Fundus photo; 1924 x 1556 pixels: 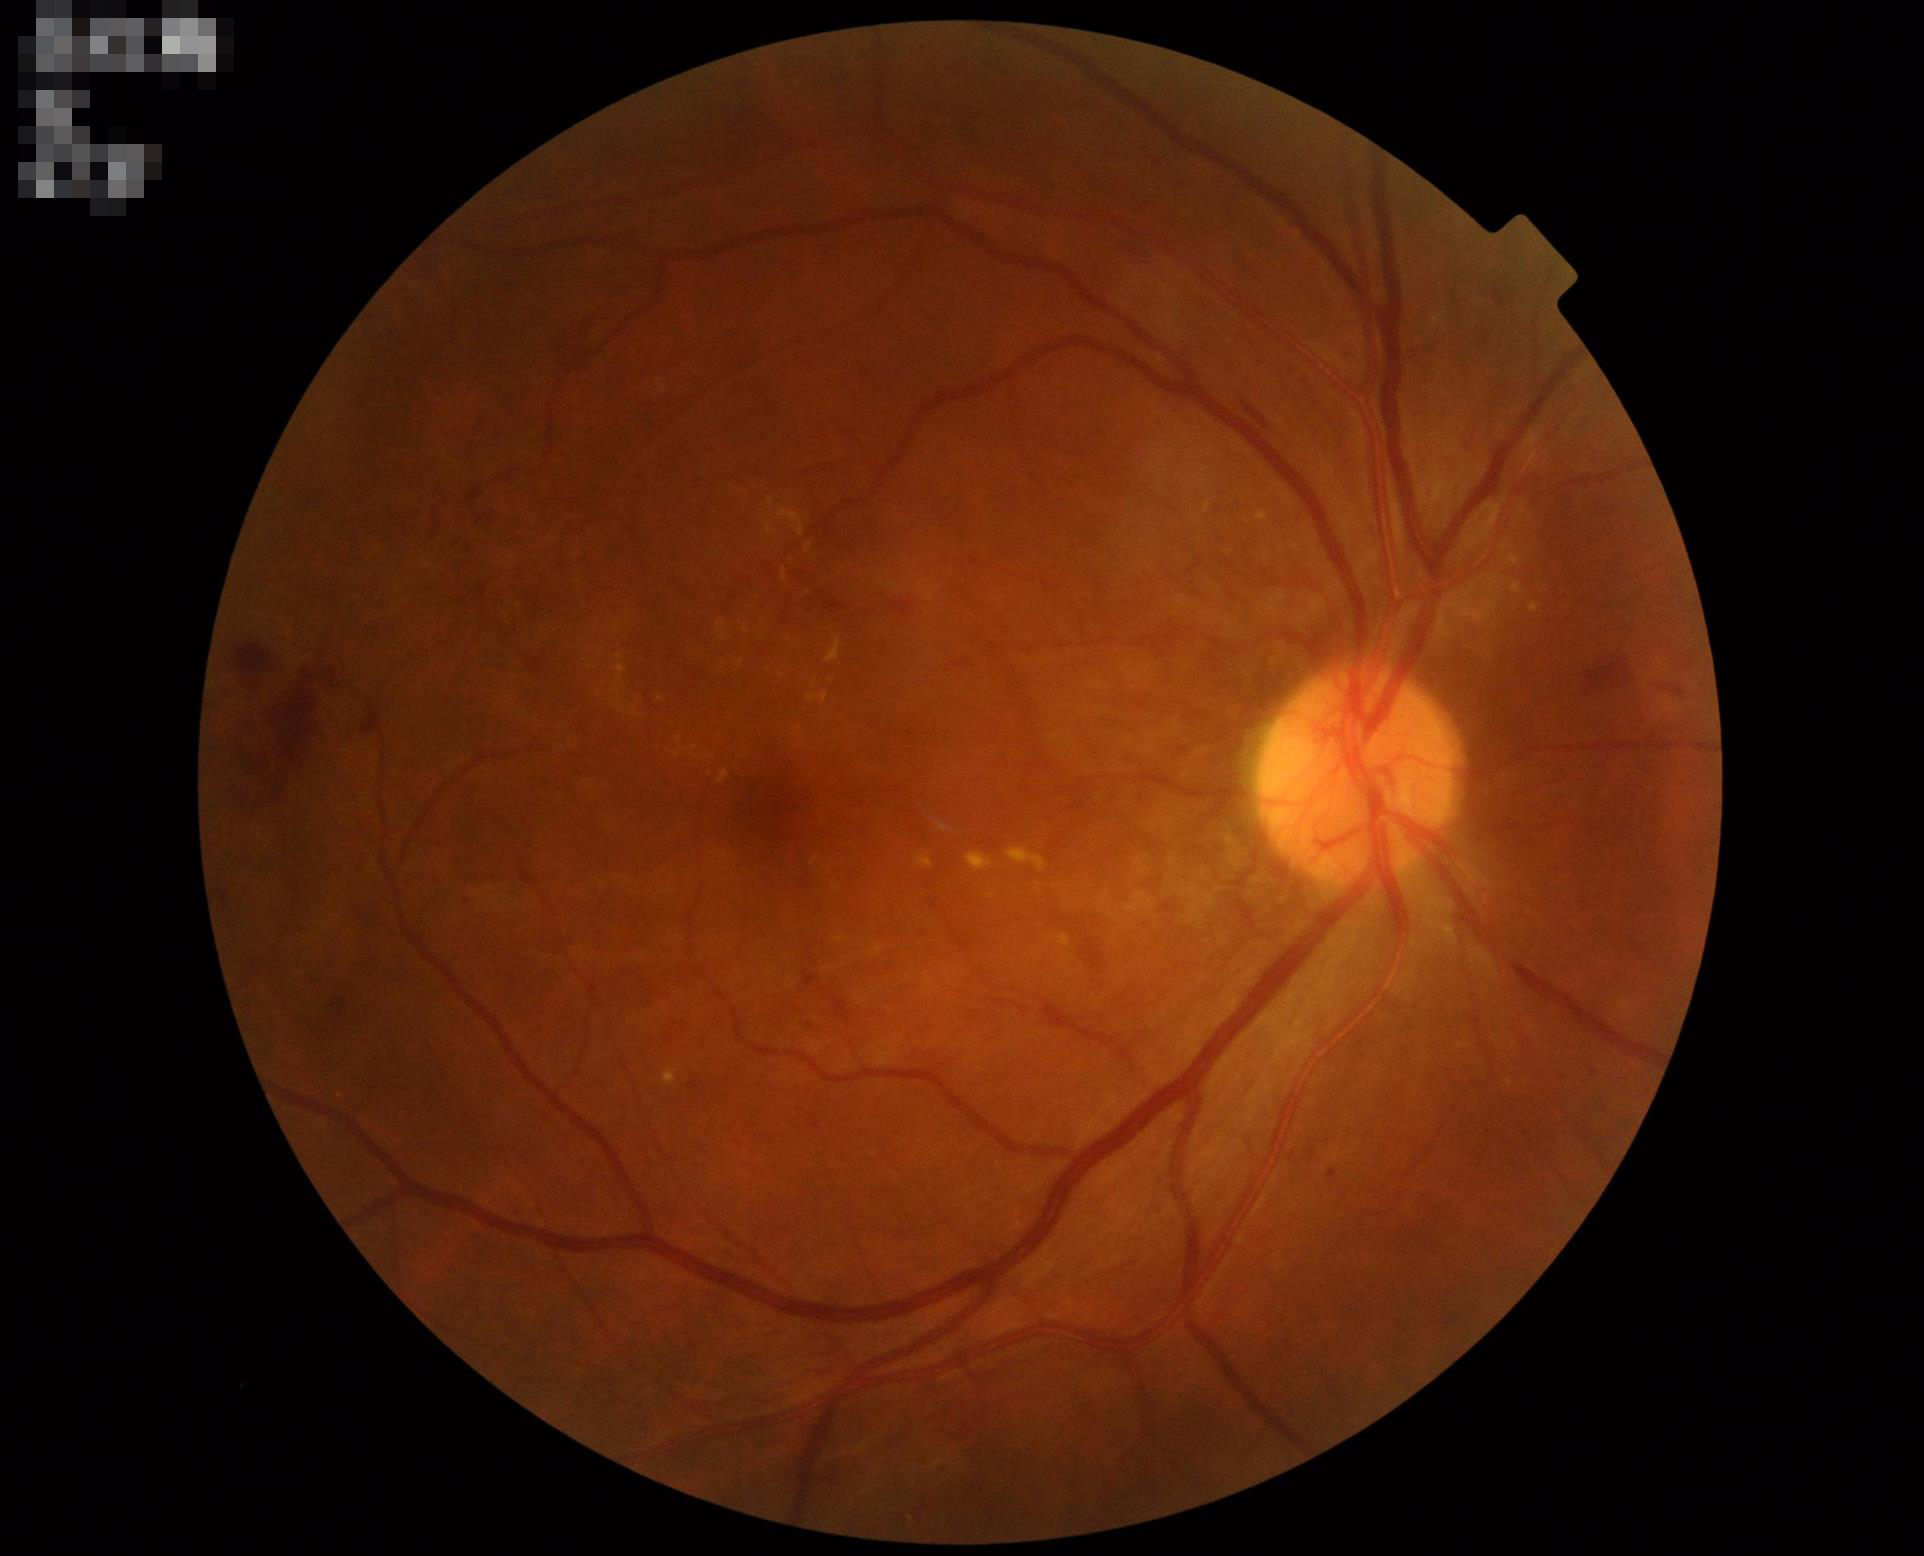   overall_quality: good
  clarity: in focus
  illumination: good
  contrast: good